Color fundus photograph:
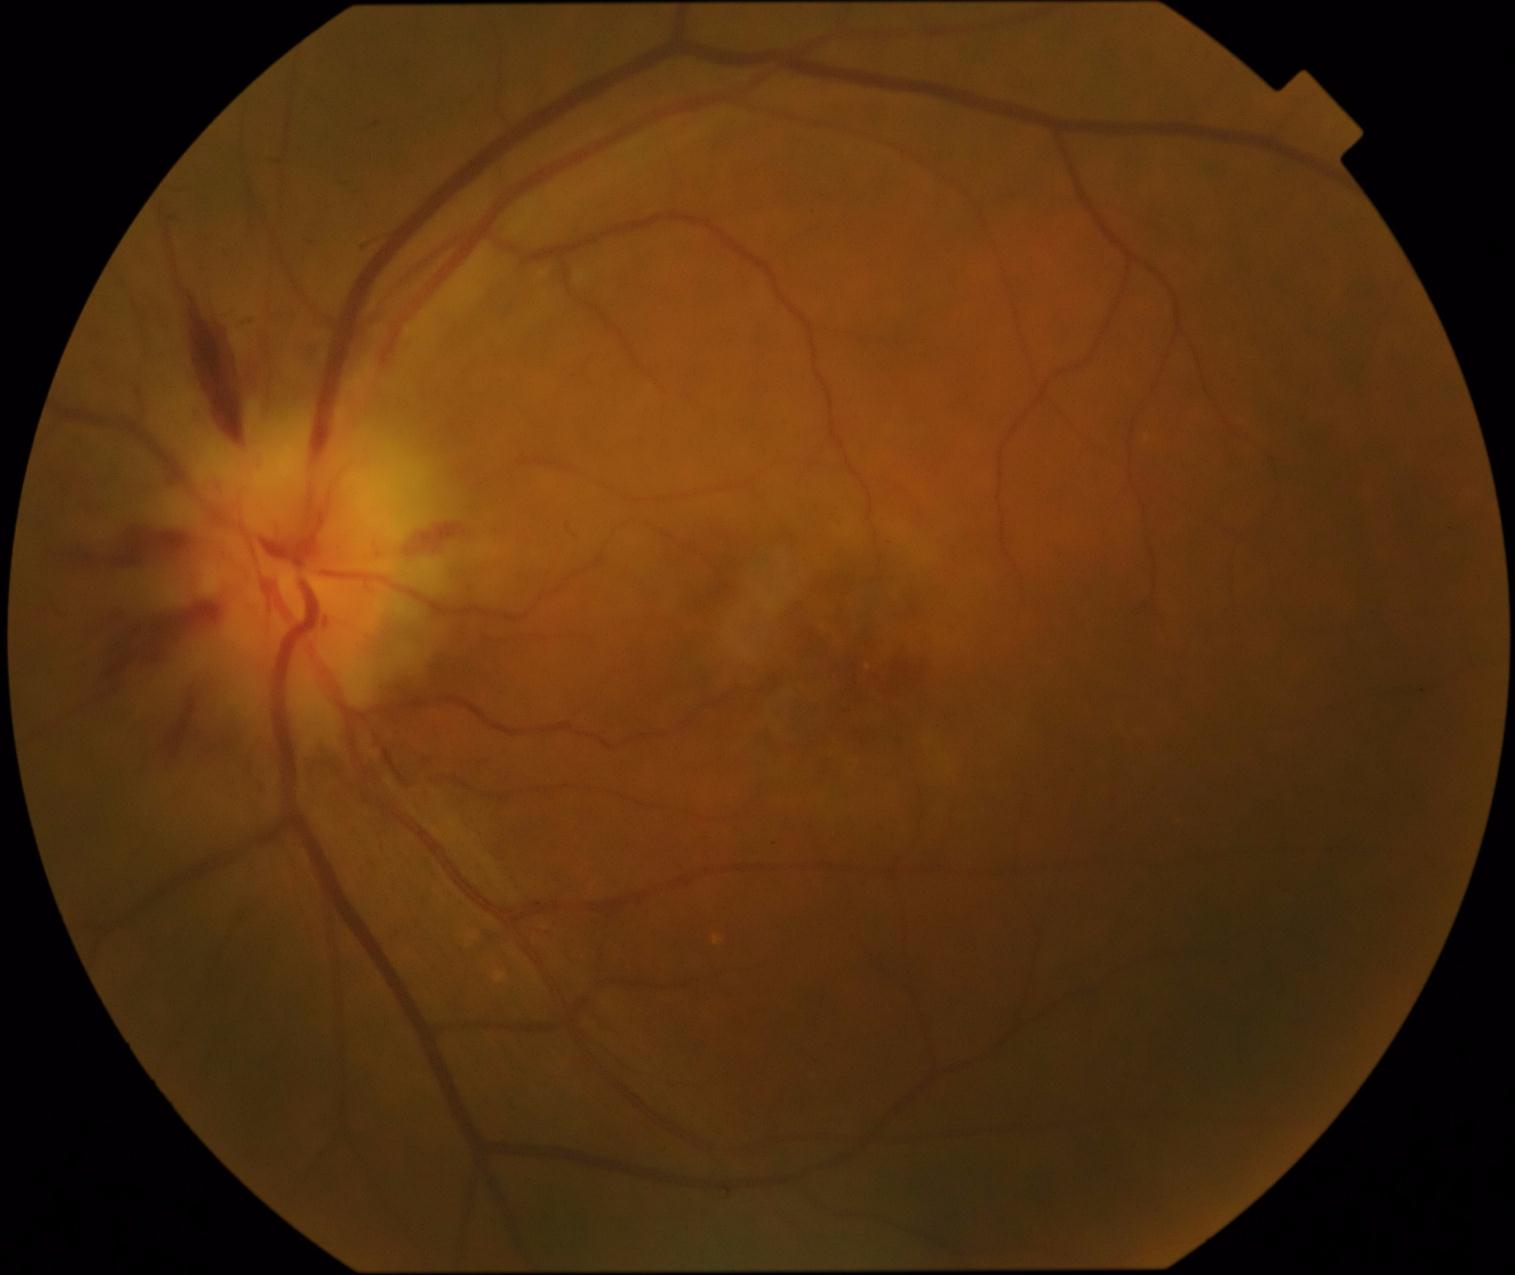
Diabetic retinopathy (DR): moderate NPDR (grade 2) — more than just microaneurysms but less than severe NPDR.